Camera: Phoenix ICON (100° FOV); wide-field fundus photograph of an infant.
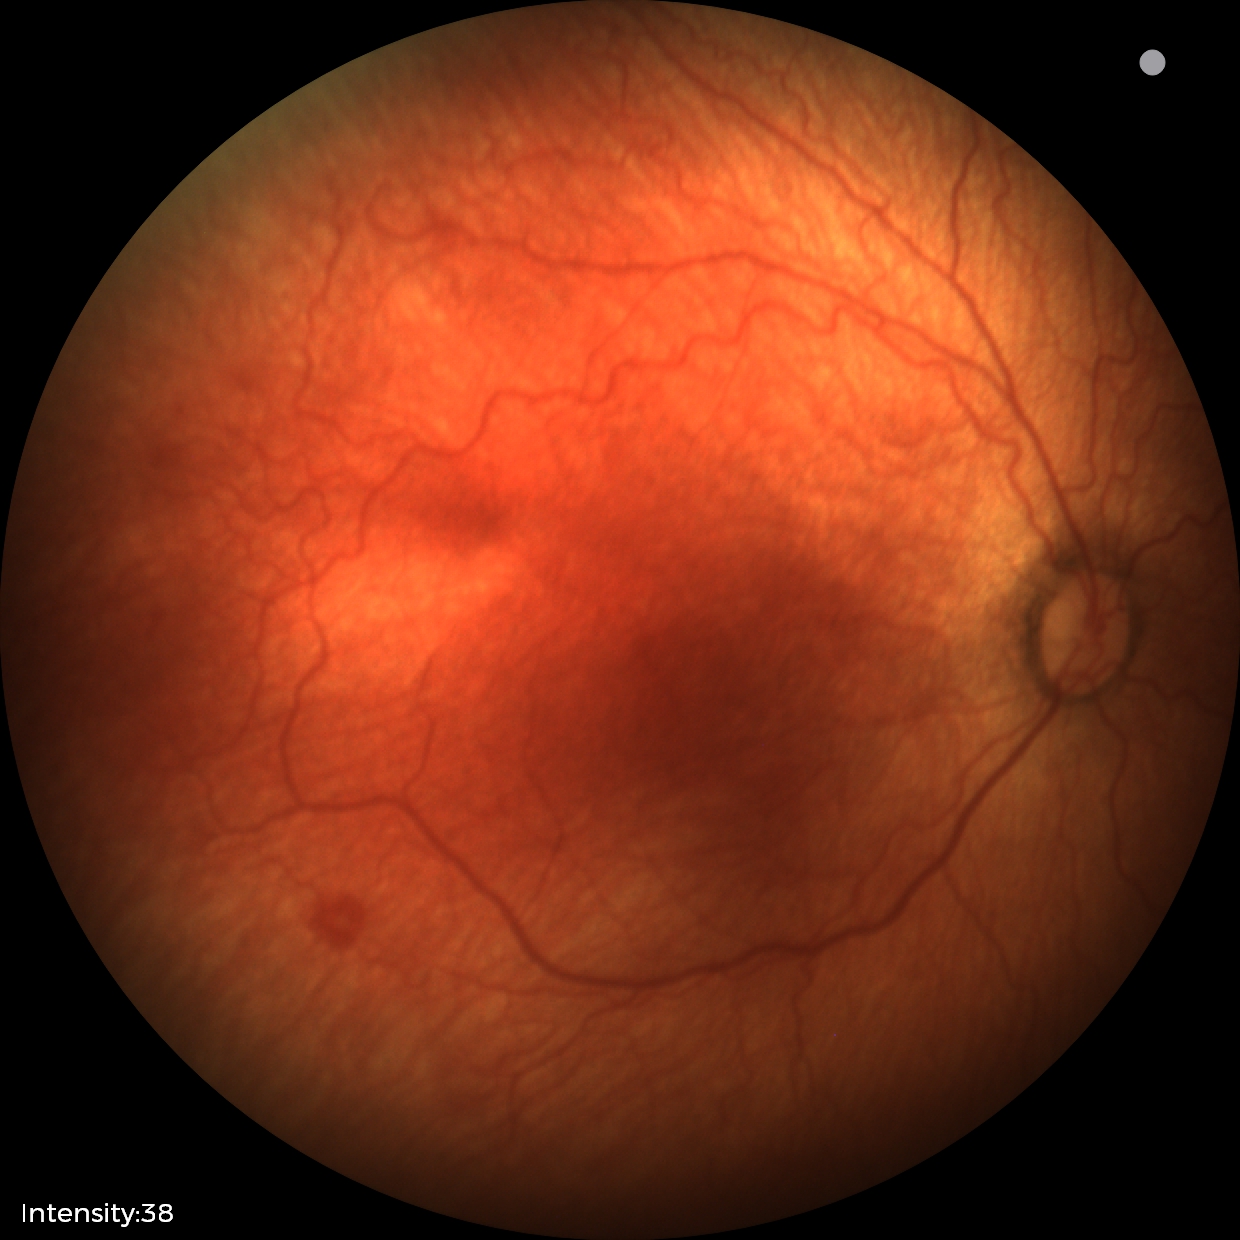
Q: What is the screening diagnosis?
A: retinopathy of prematurity stage 1
Q: Is plus disease present?
A: no plus disease